Image size 2352x1568 · 45-degree field of view · color fundus image: 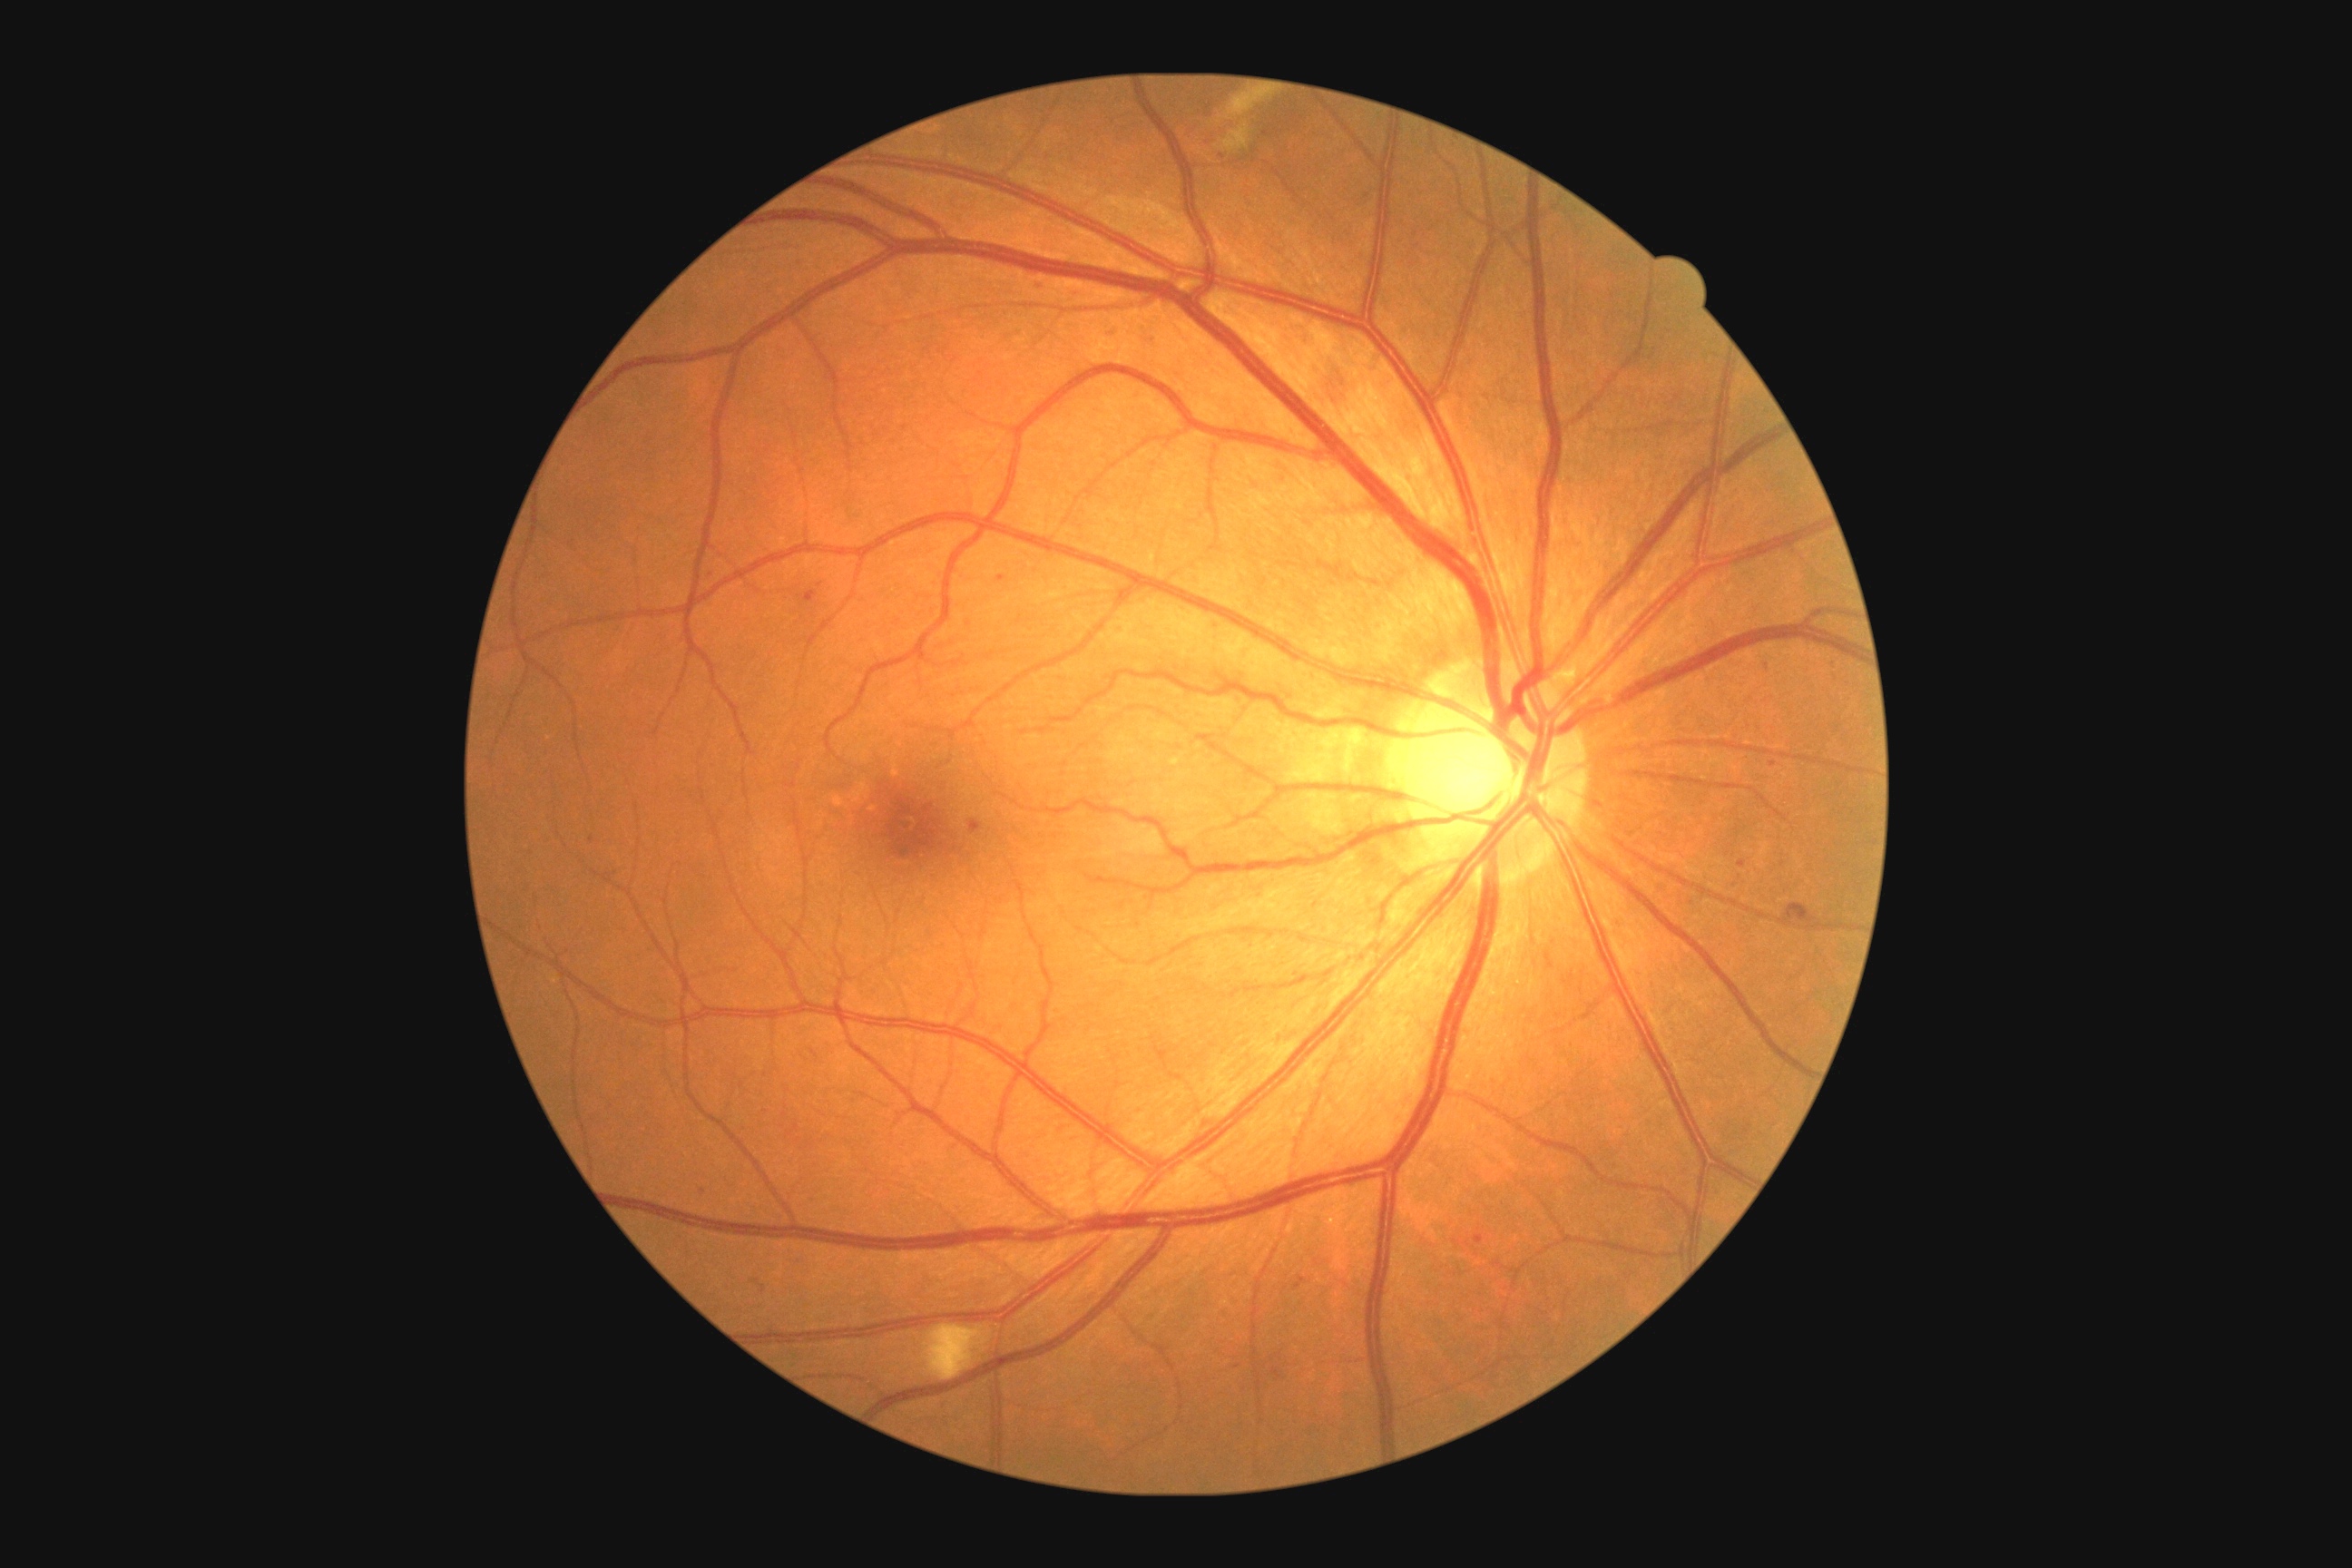
Diabetic retinopathy (DR) is grade 2 (moderate NPDR)
Lesions identified (partial list):
hemorrhages (HEs) (subset): l=1783, t=903, r=1816, b=921 | l=1324, t=378, r=1351, b=400
microaneurysms (MAs) (subset): l=1148, t=337, r=1155, b=346 | l=1475, t=1235, r=1484, b=1244 | l=752, t=1280, r=760, b=1284 | l=997, t=576, r=1006, b=582 | l=1770, t=761, r=1778, b=769 | l=970, t=819, r=983, b=836 | l=1295, t=1279, r=1308, b=1289
Small MAs approximately at <point>710, 576</point> | <point>591, 840</point> | <point>1238, 1367</point> | <point>1742, 864</point>
soft exudates (SEs): l=1228, t=92, r=1271, b=119 | l=1222, t=124, r=1250, b=152 | l=925, t=1326, r=986, b=1382
hard exudates (EXs): none detected